Camera: Topcon TRC-50DX:
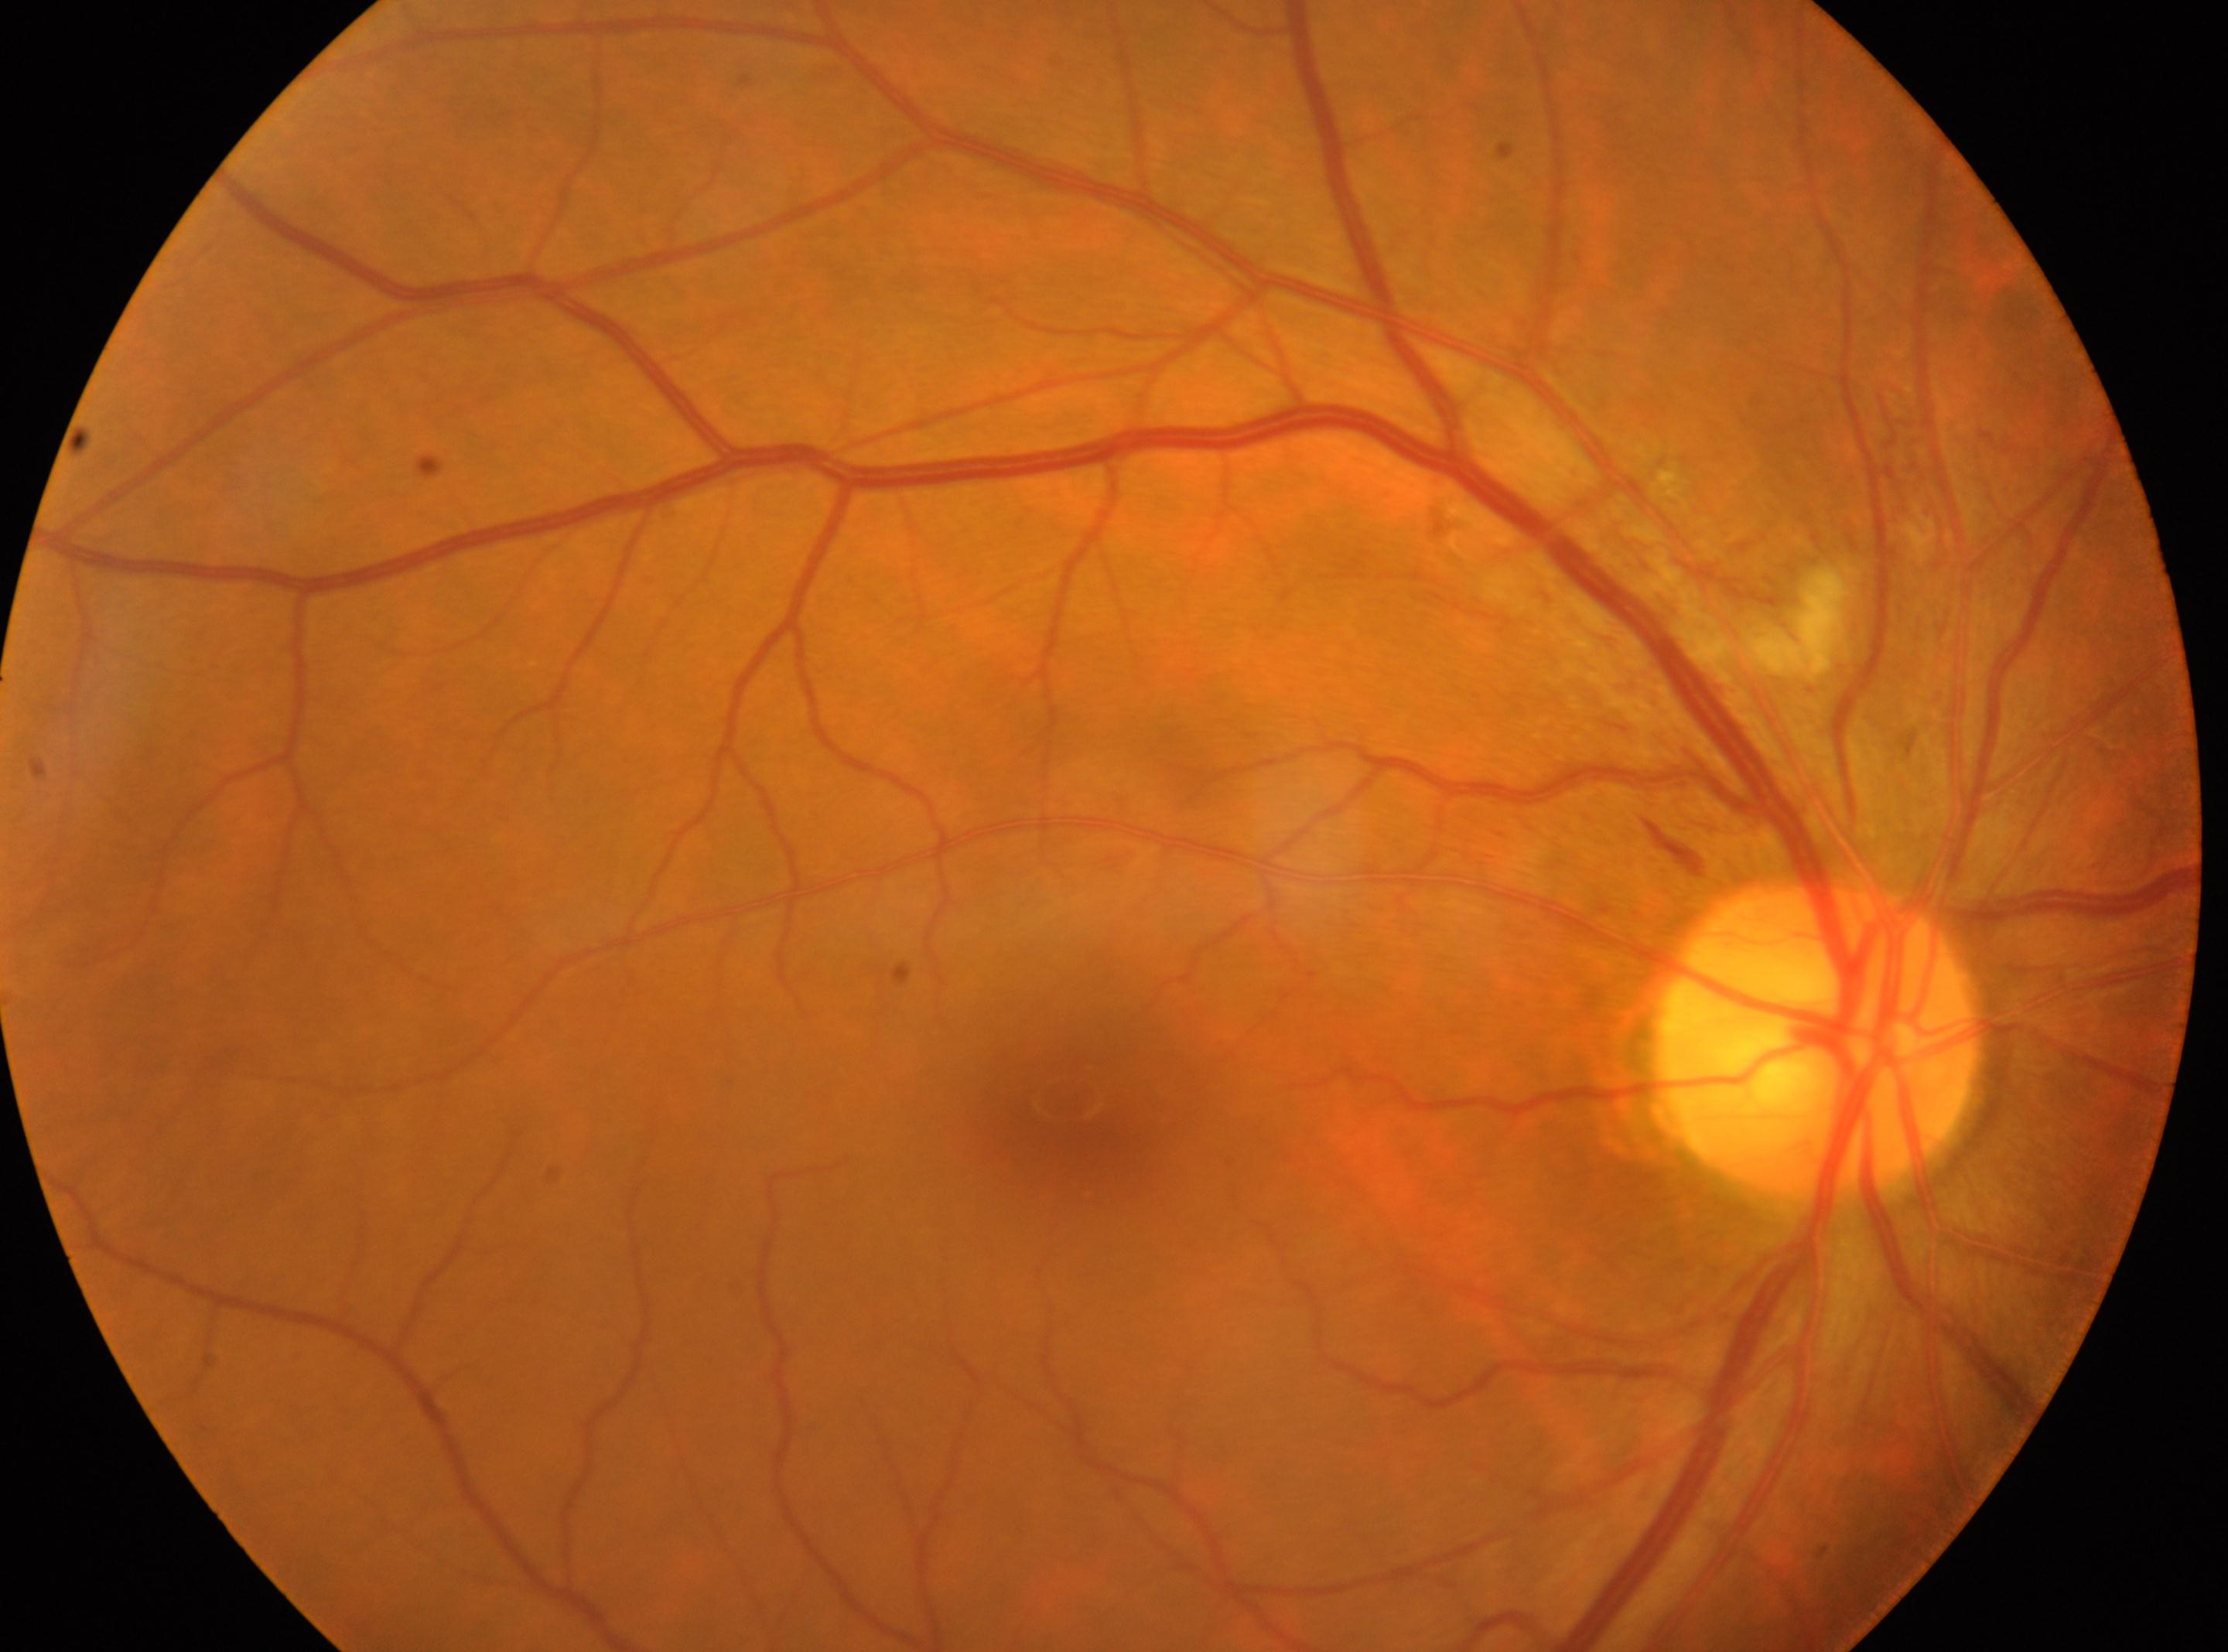

Optic disk located at (1813,1039). Fovea center located at (1069,1103). The image shows the right eye. Diabetic retinopathy (DR) is 2 — more than just microaneurysms but less than severe NPDR.